No pharmacologic dilation, NIDEK AFC-230 fundus camera, 848 by 848 pixels: 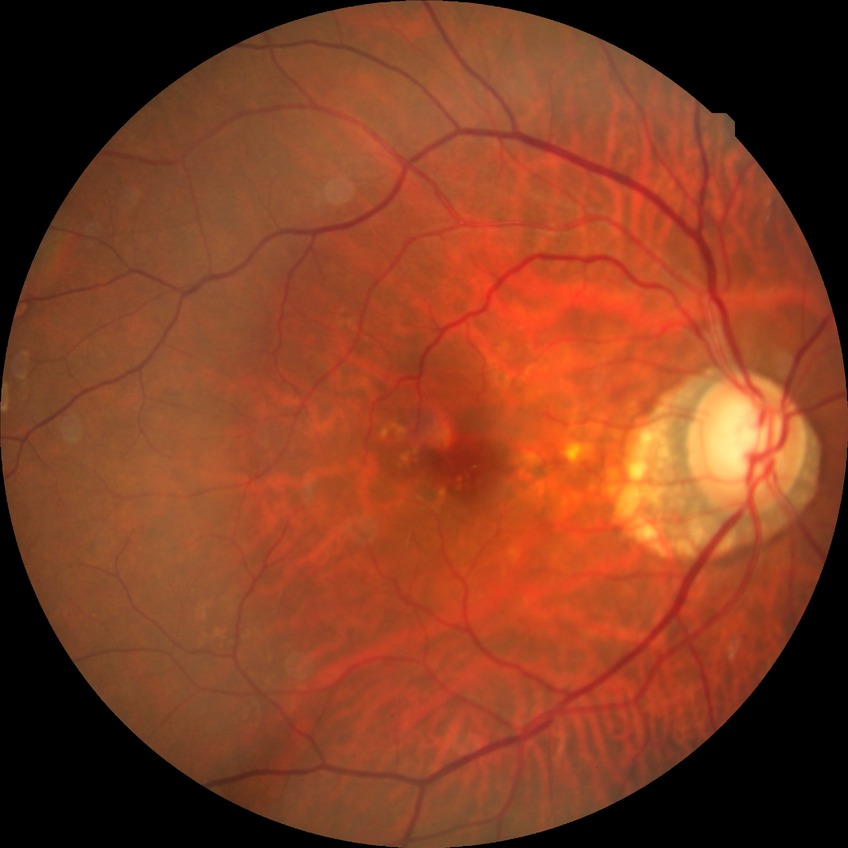 diabetic retinopathy stage = no diabetic retinopathy.